Infant wide-field retinal image · camera: Phoenix ICON (100° FOV) · image size 1240x1240.
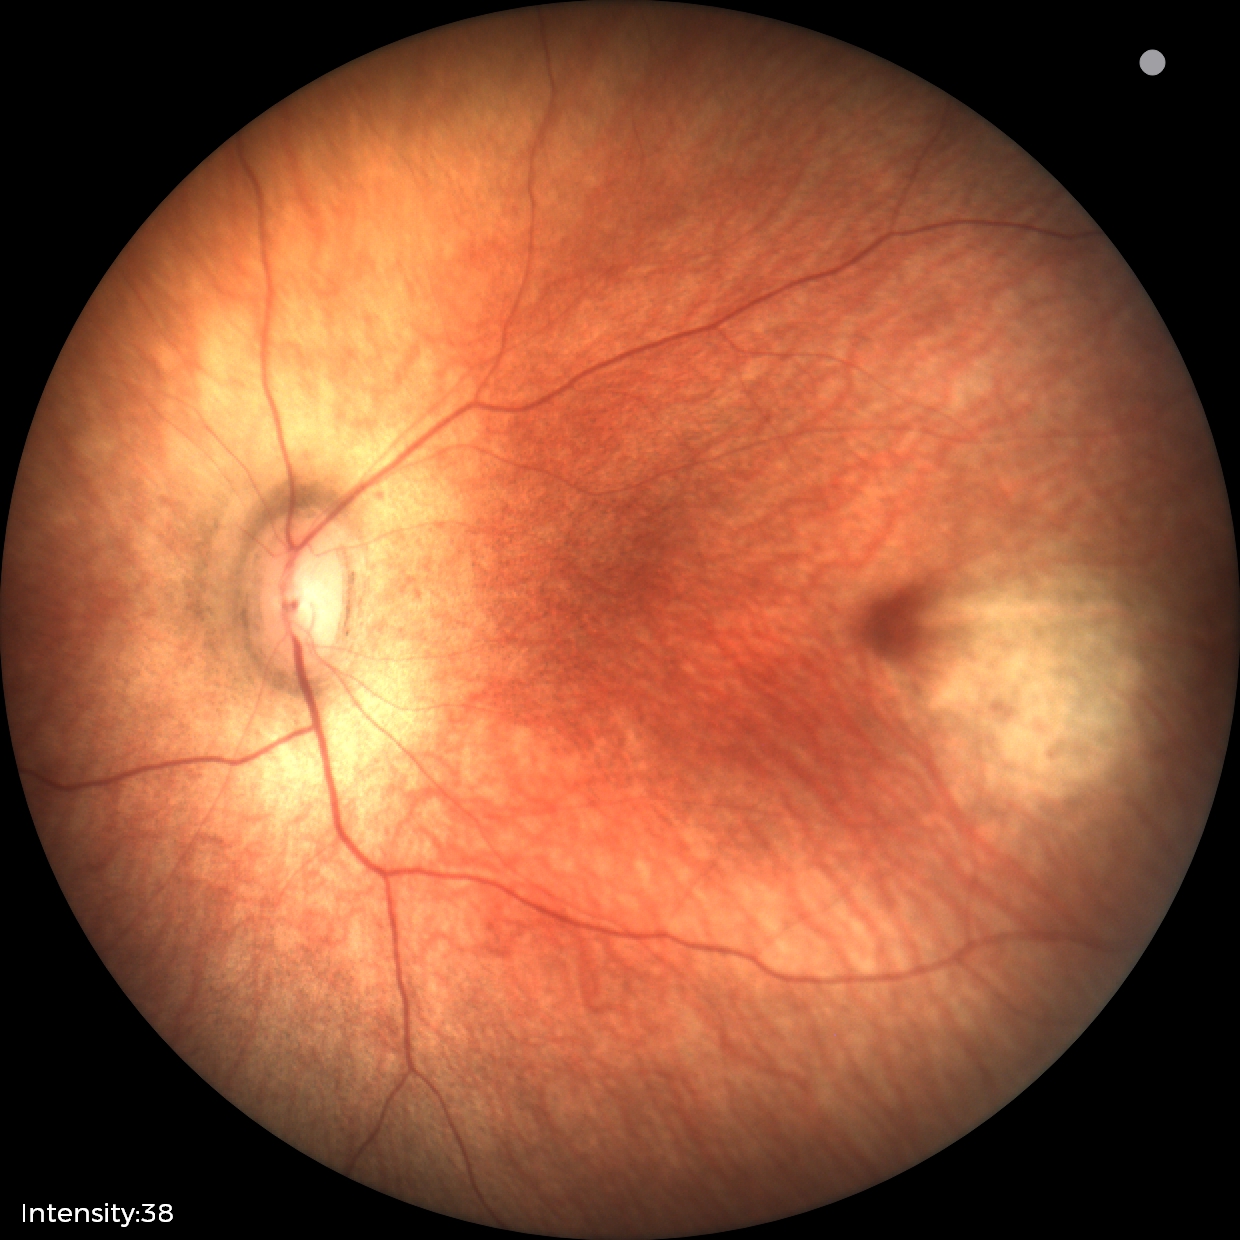
No retinal pathology identified on screening.